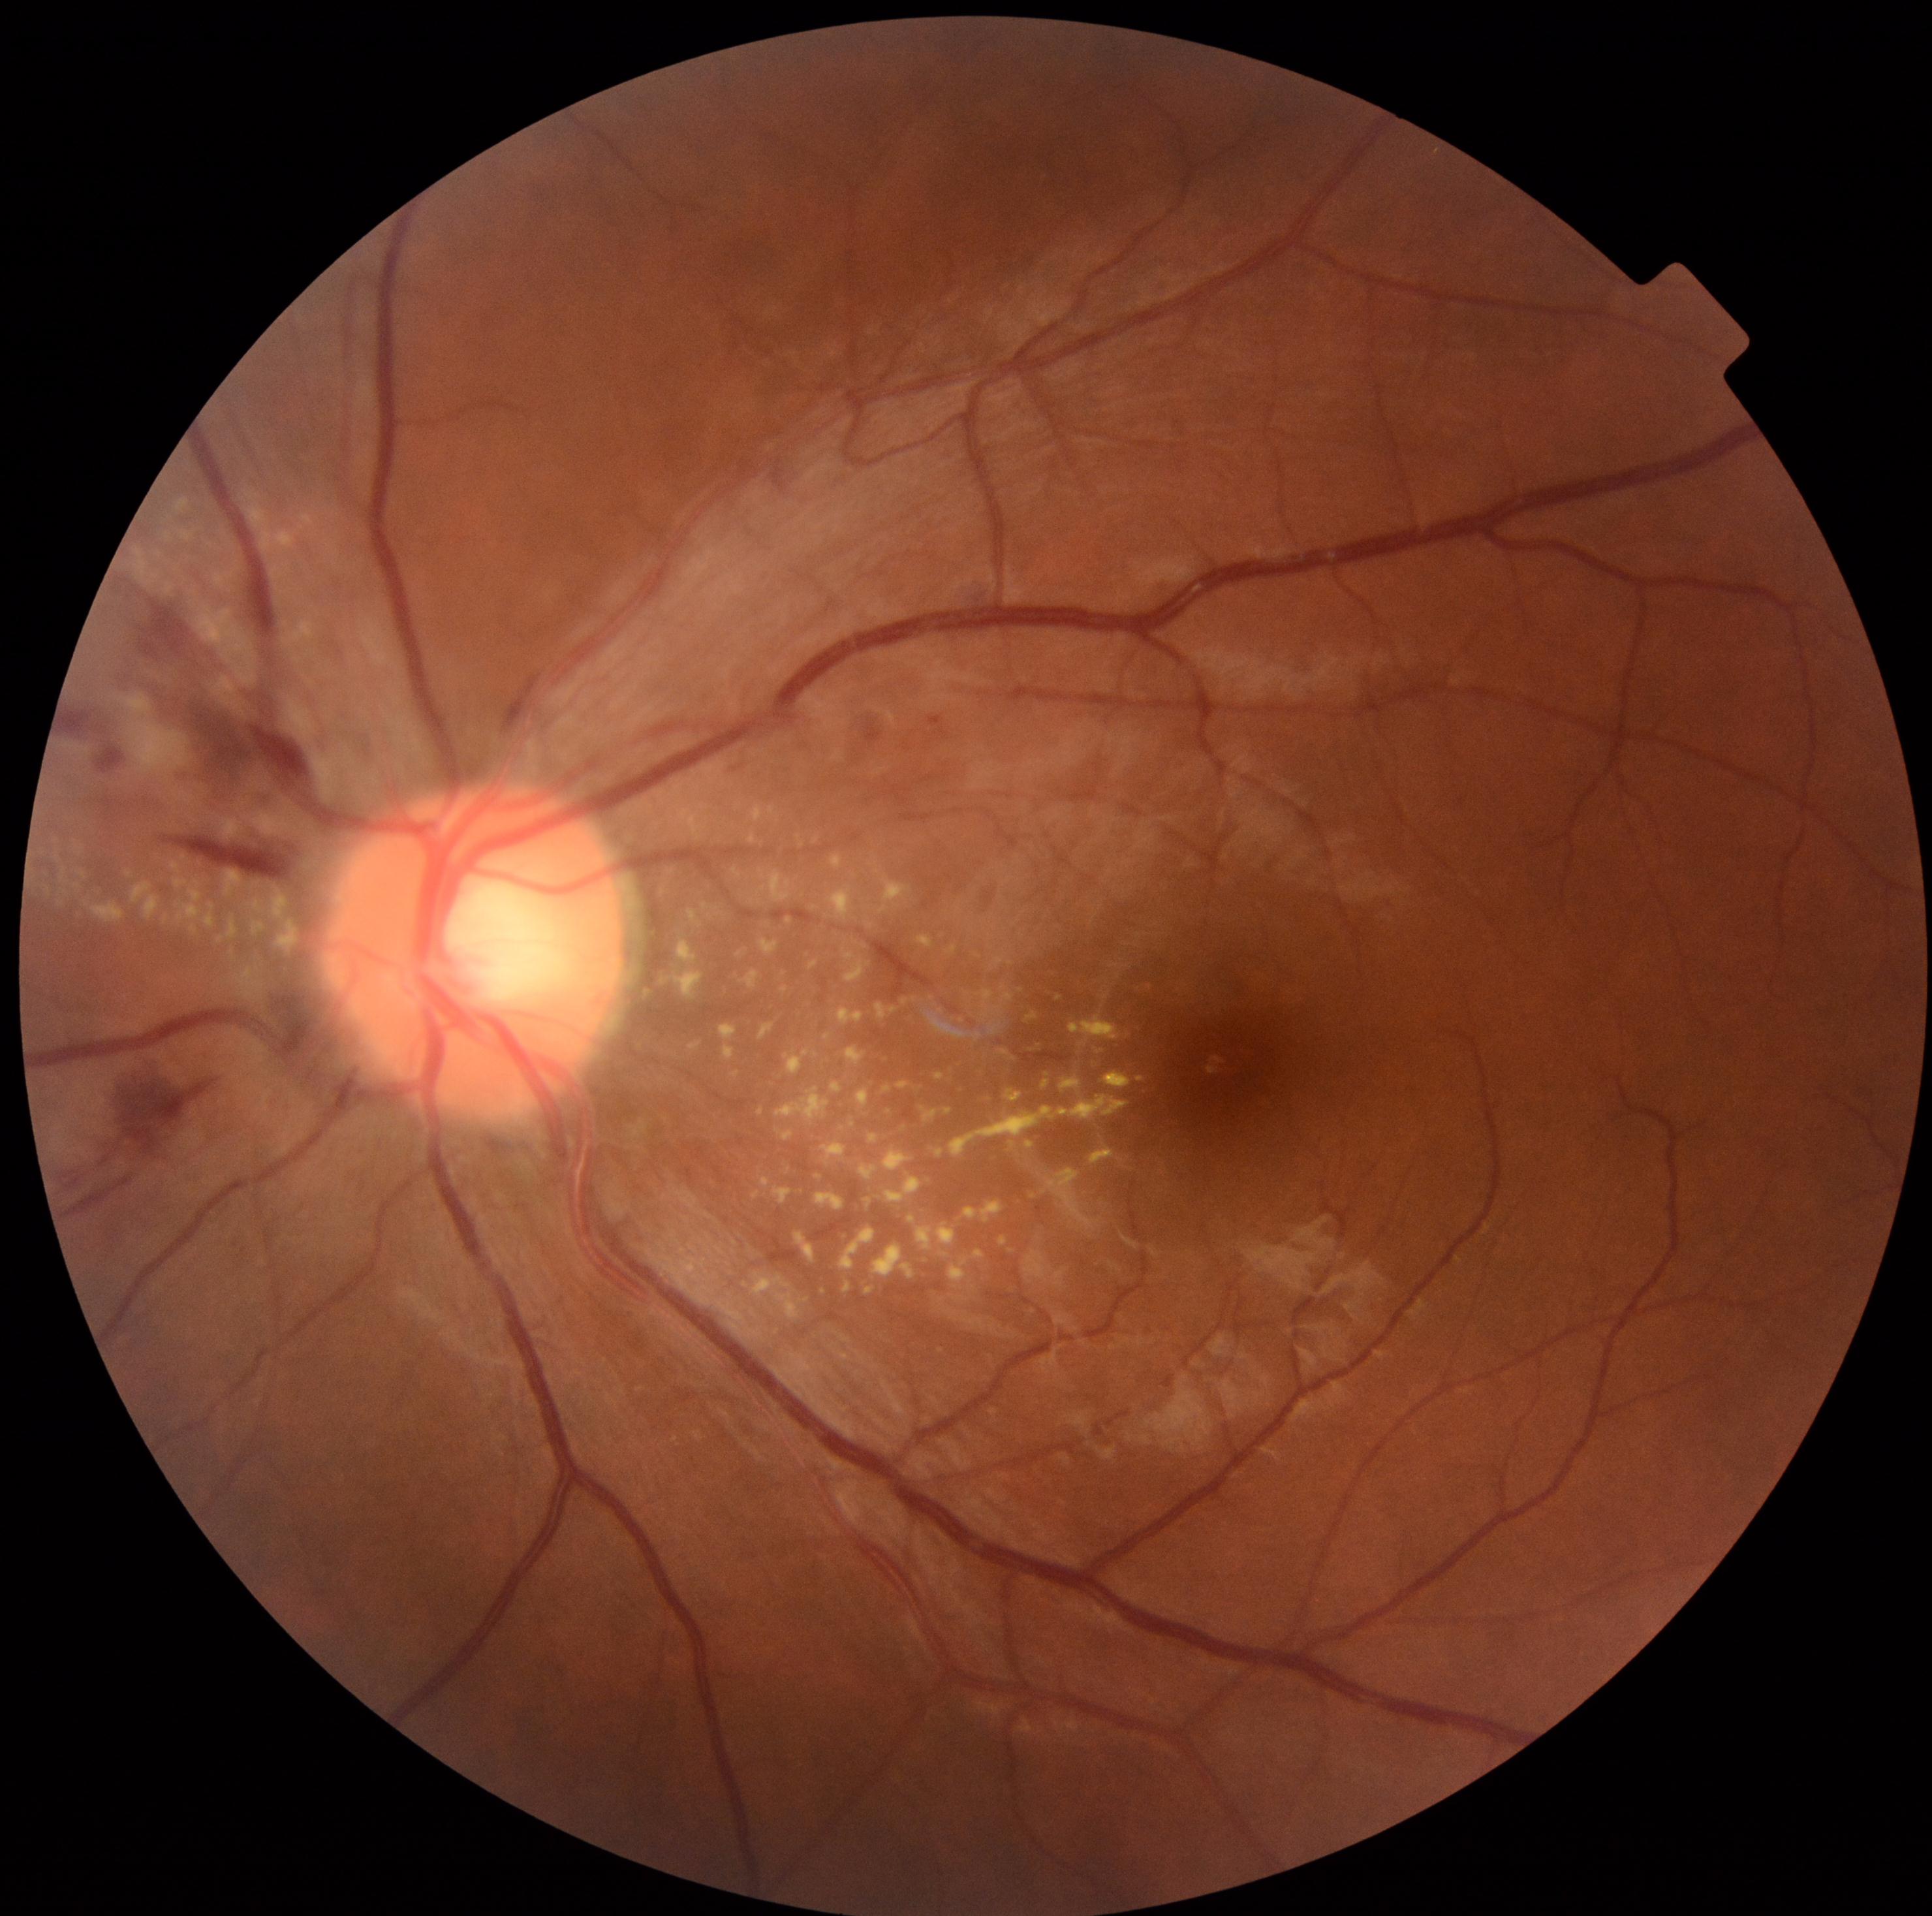

Annotations:
• diabetic retinopathy severity — grade 2 (moderate NPDR)